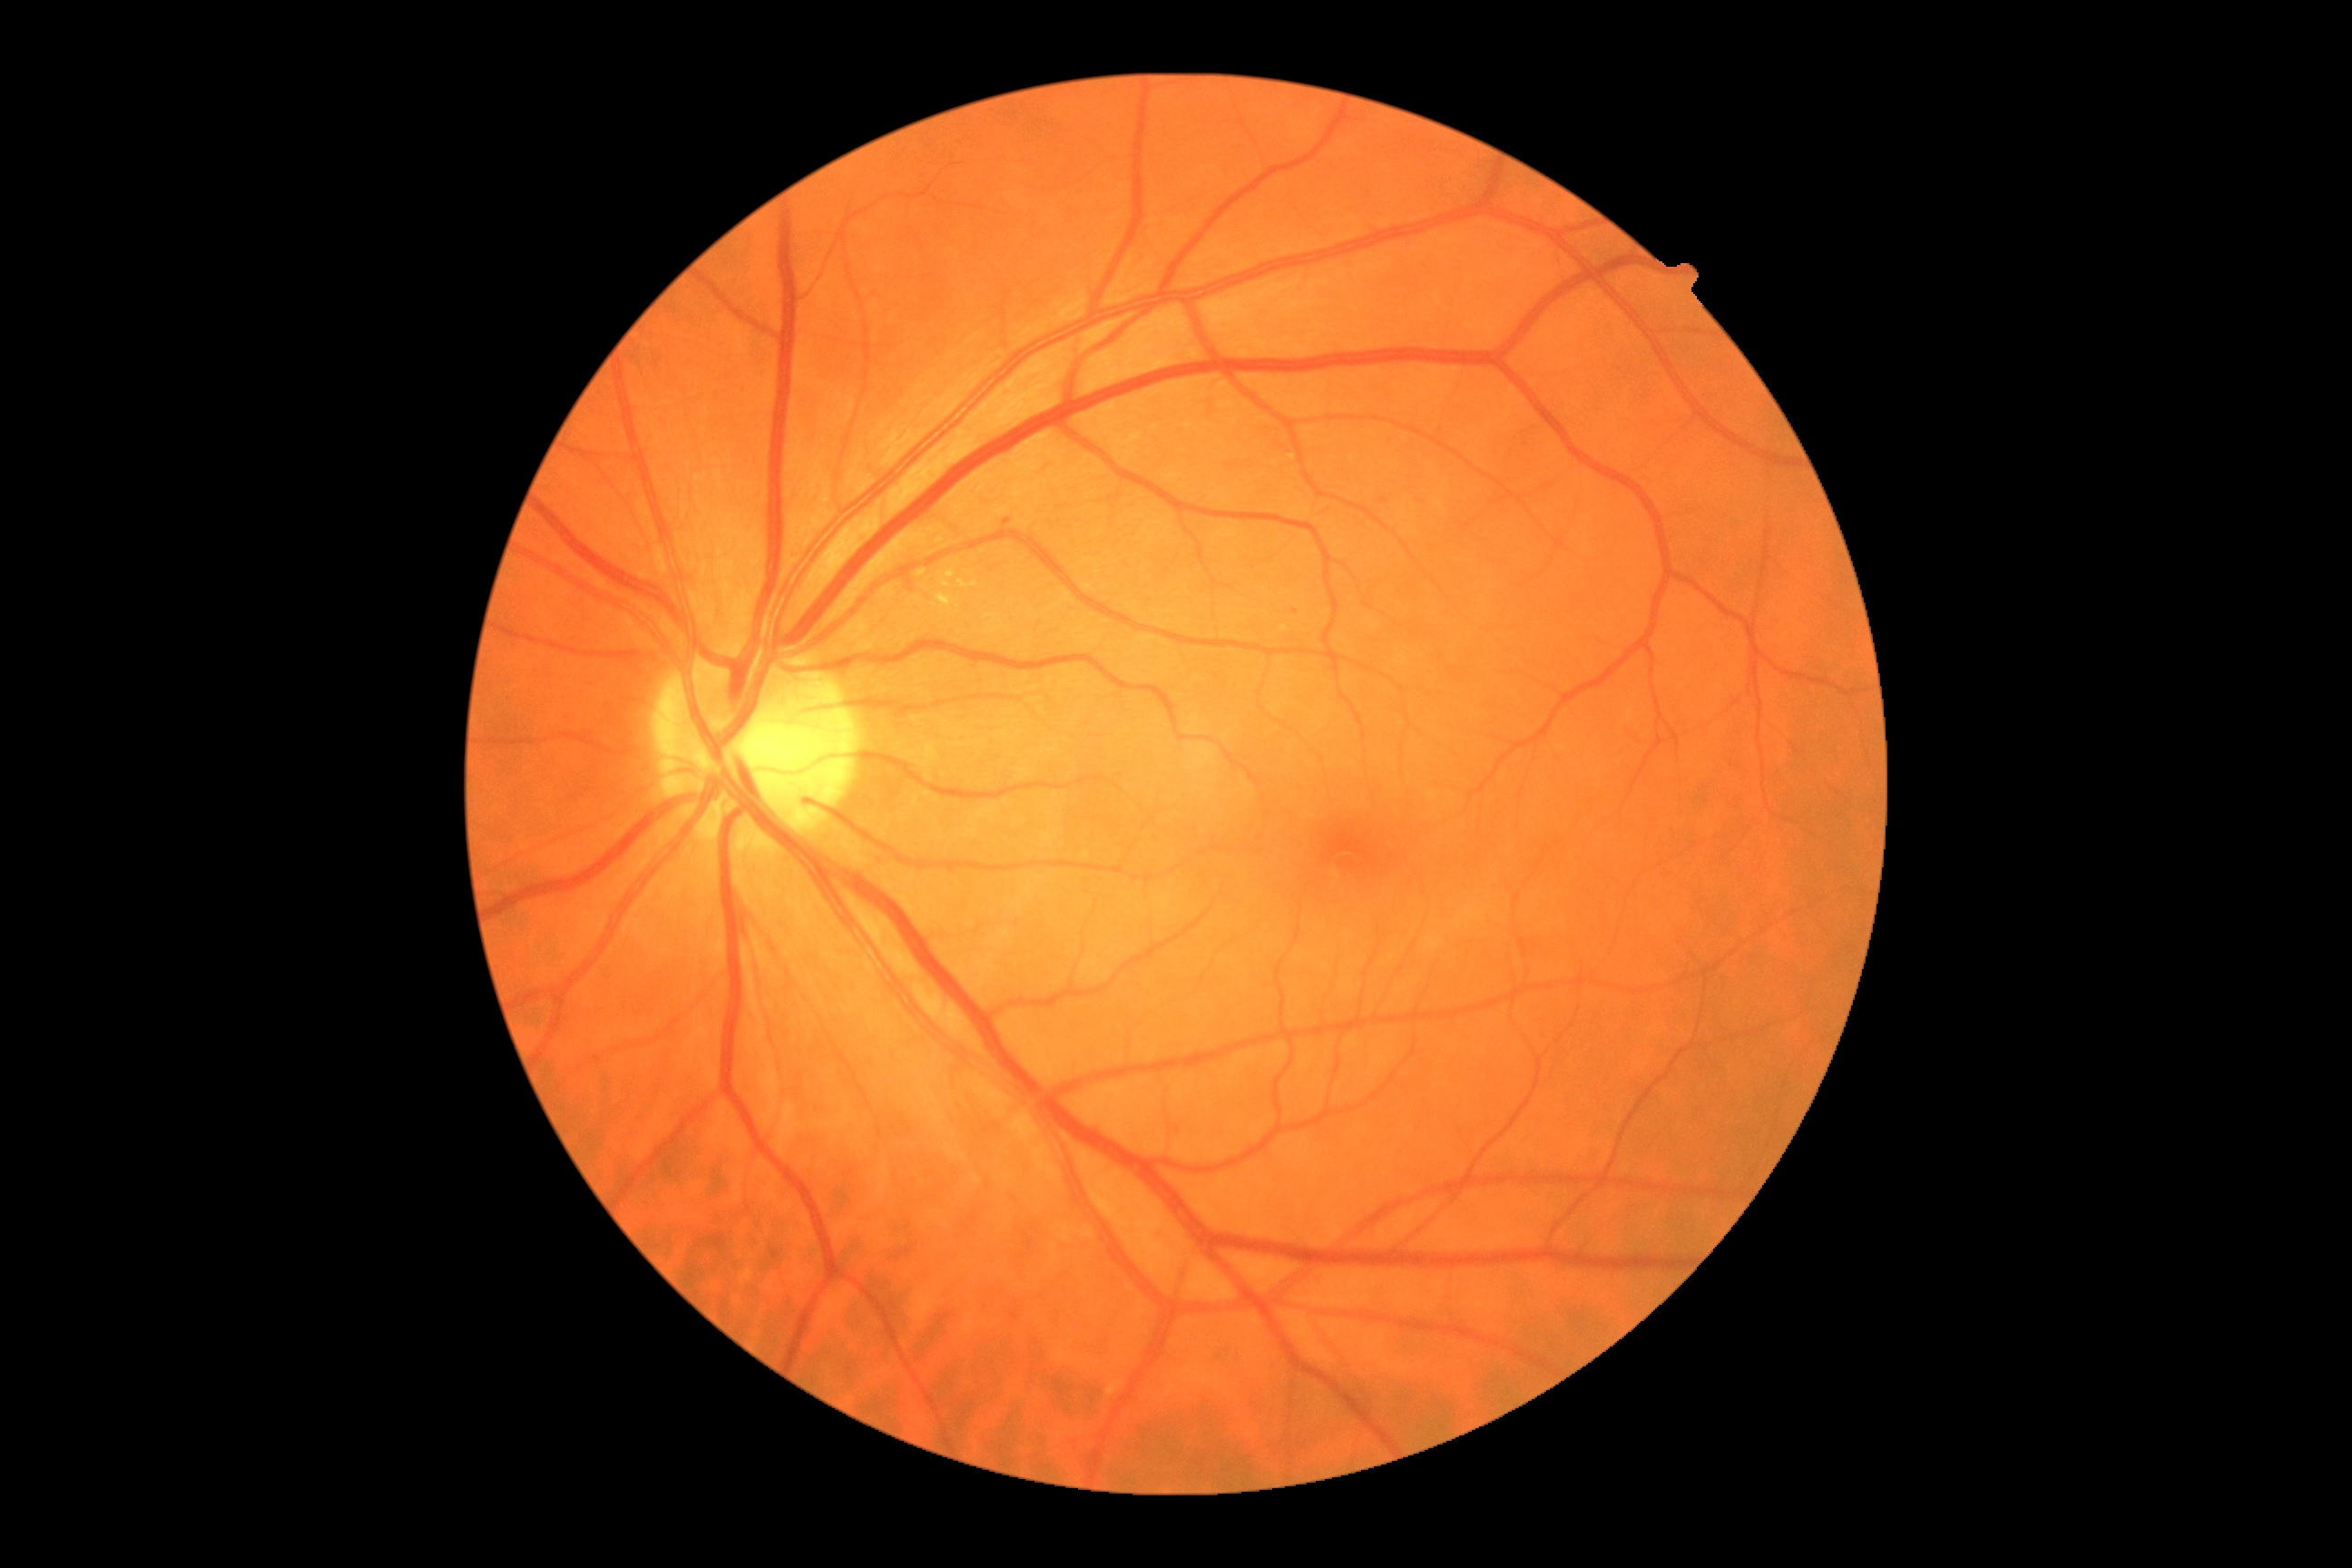

DR stage is grade 2 (moderate NPDR).